1932x1932, color fundus photograph:
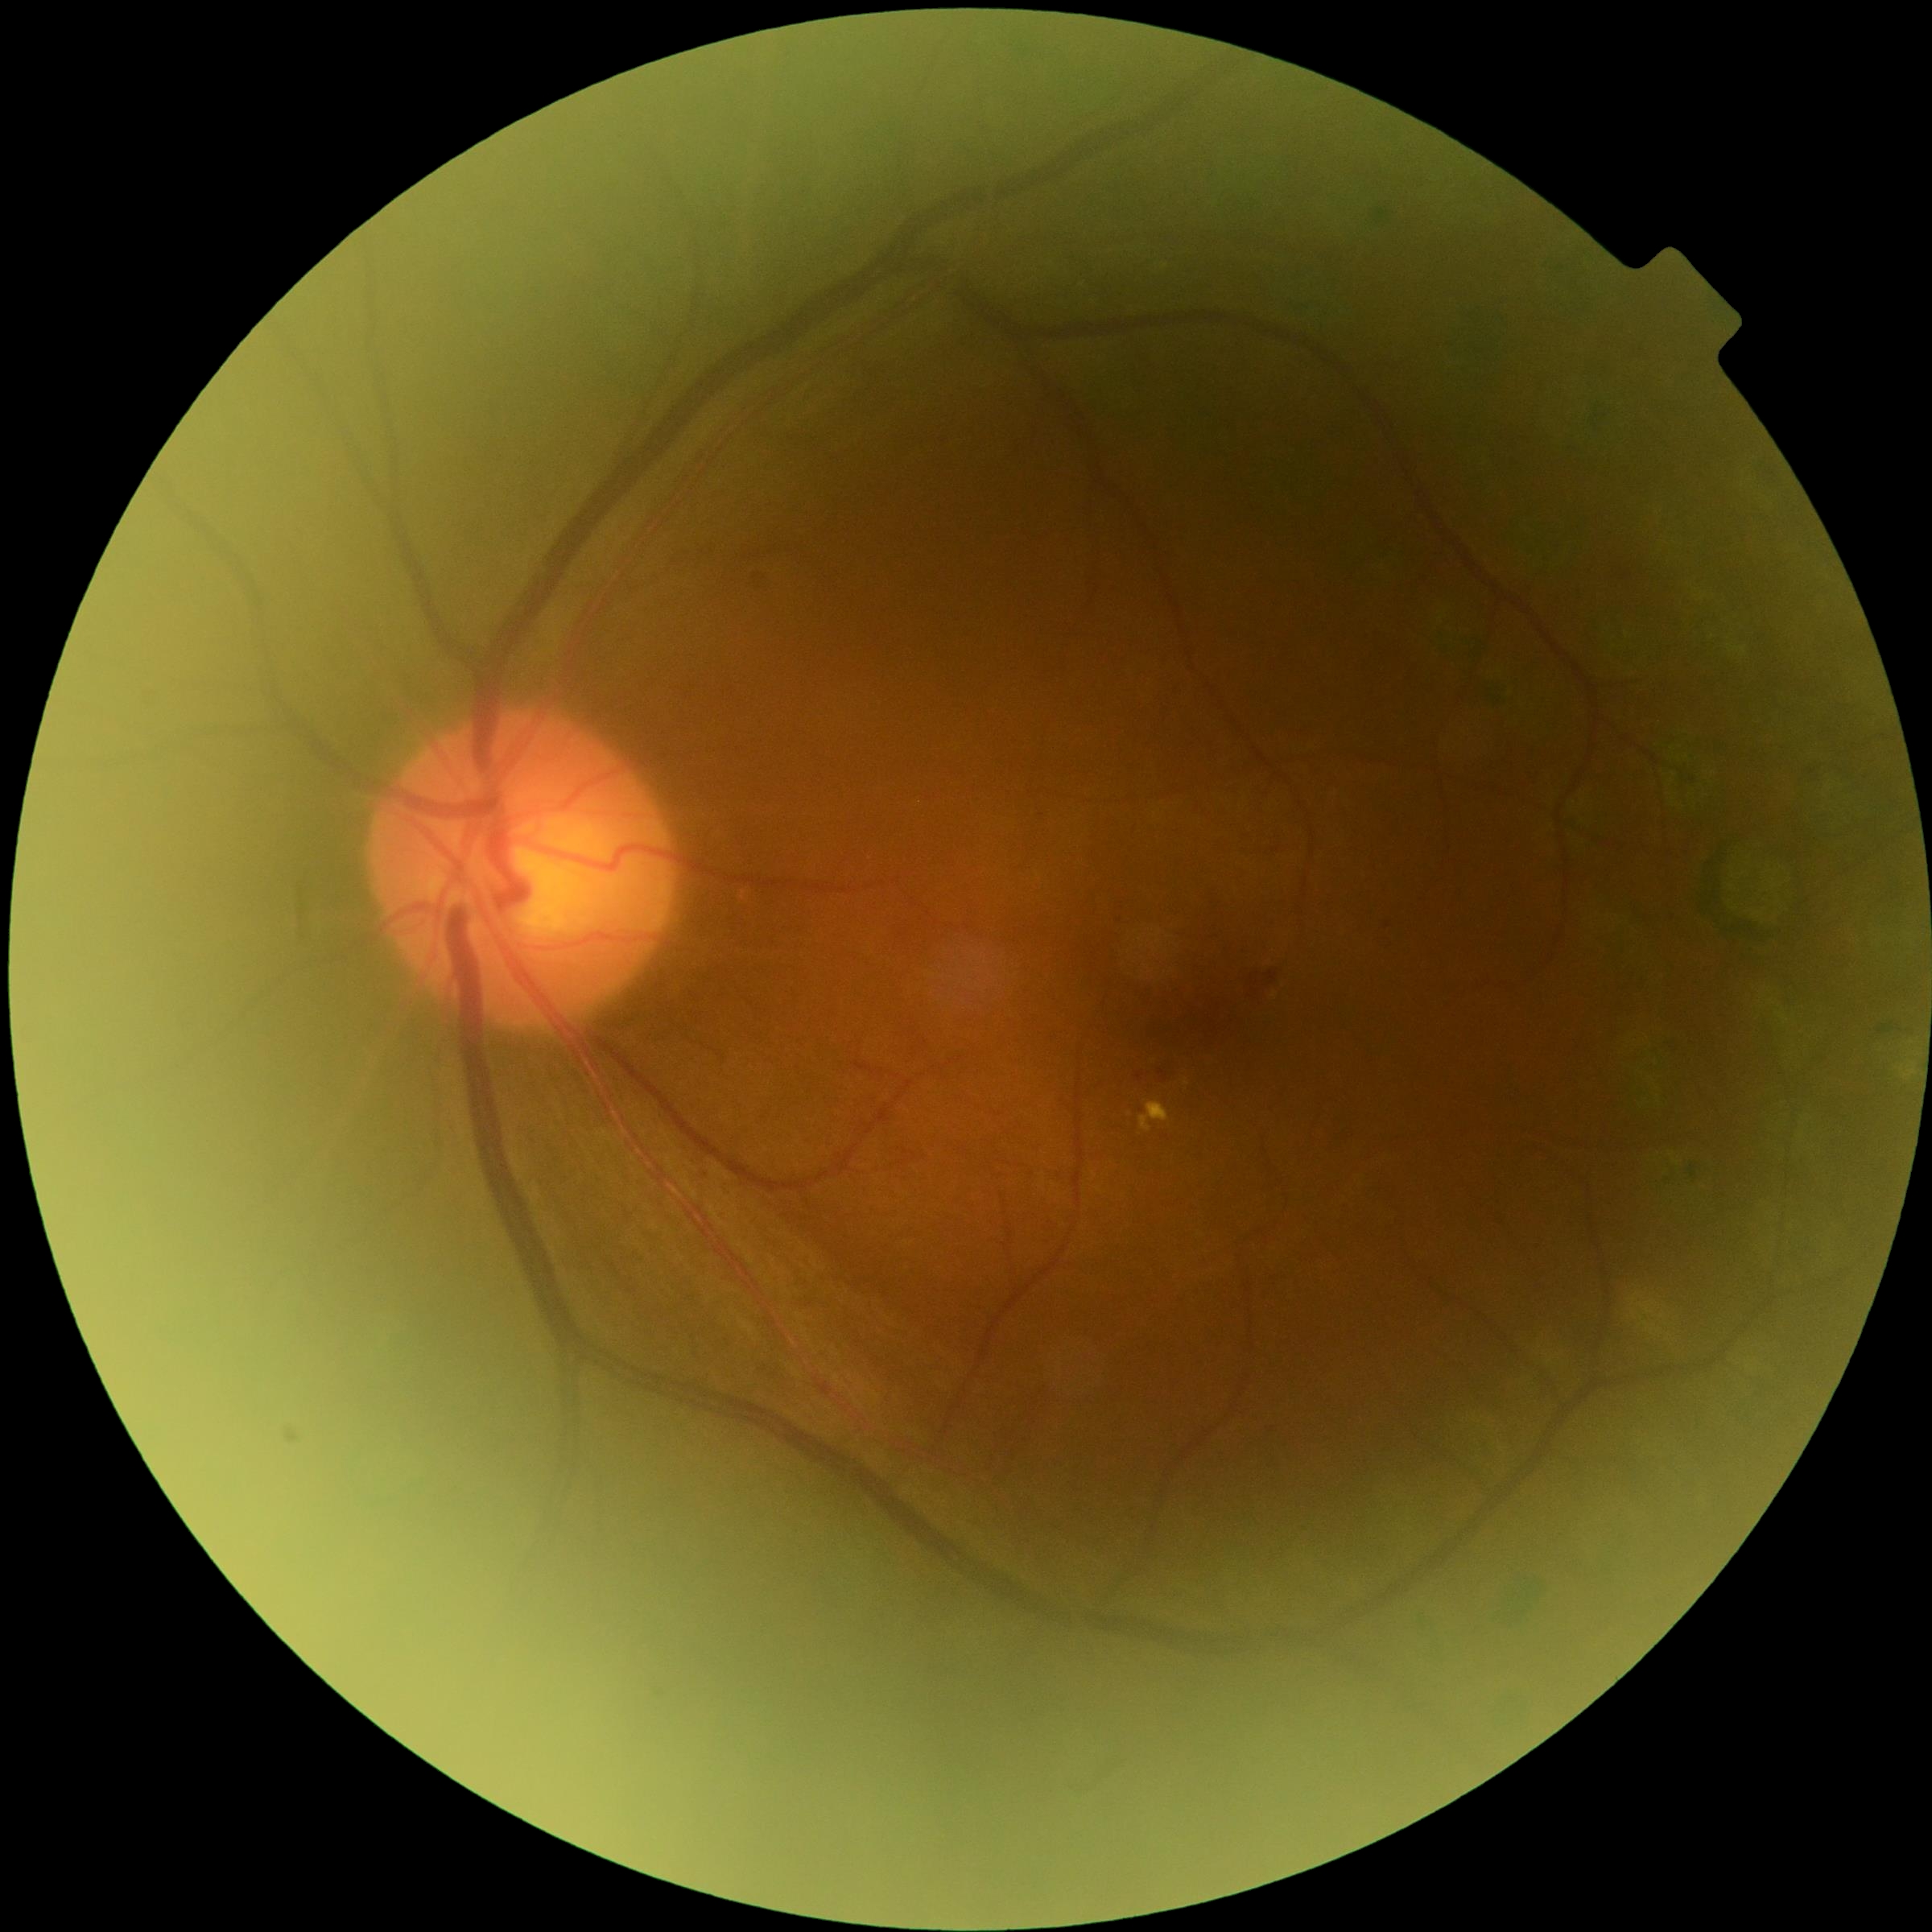

DR stage: grade 2.